2346 x 1568 pixels.
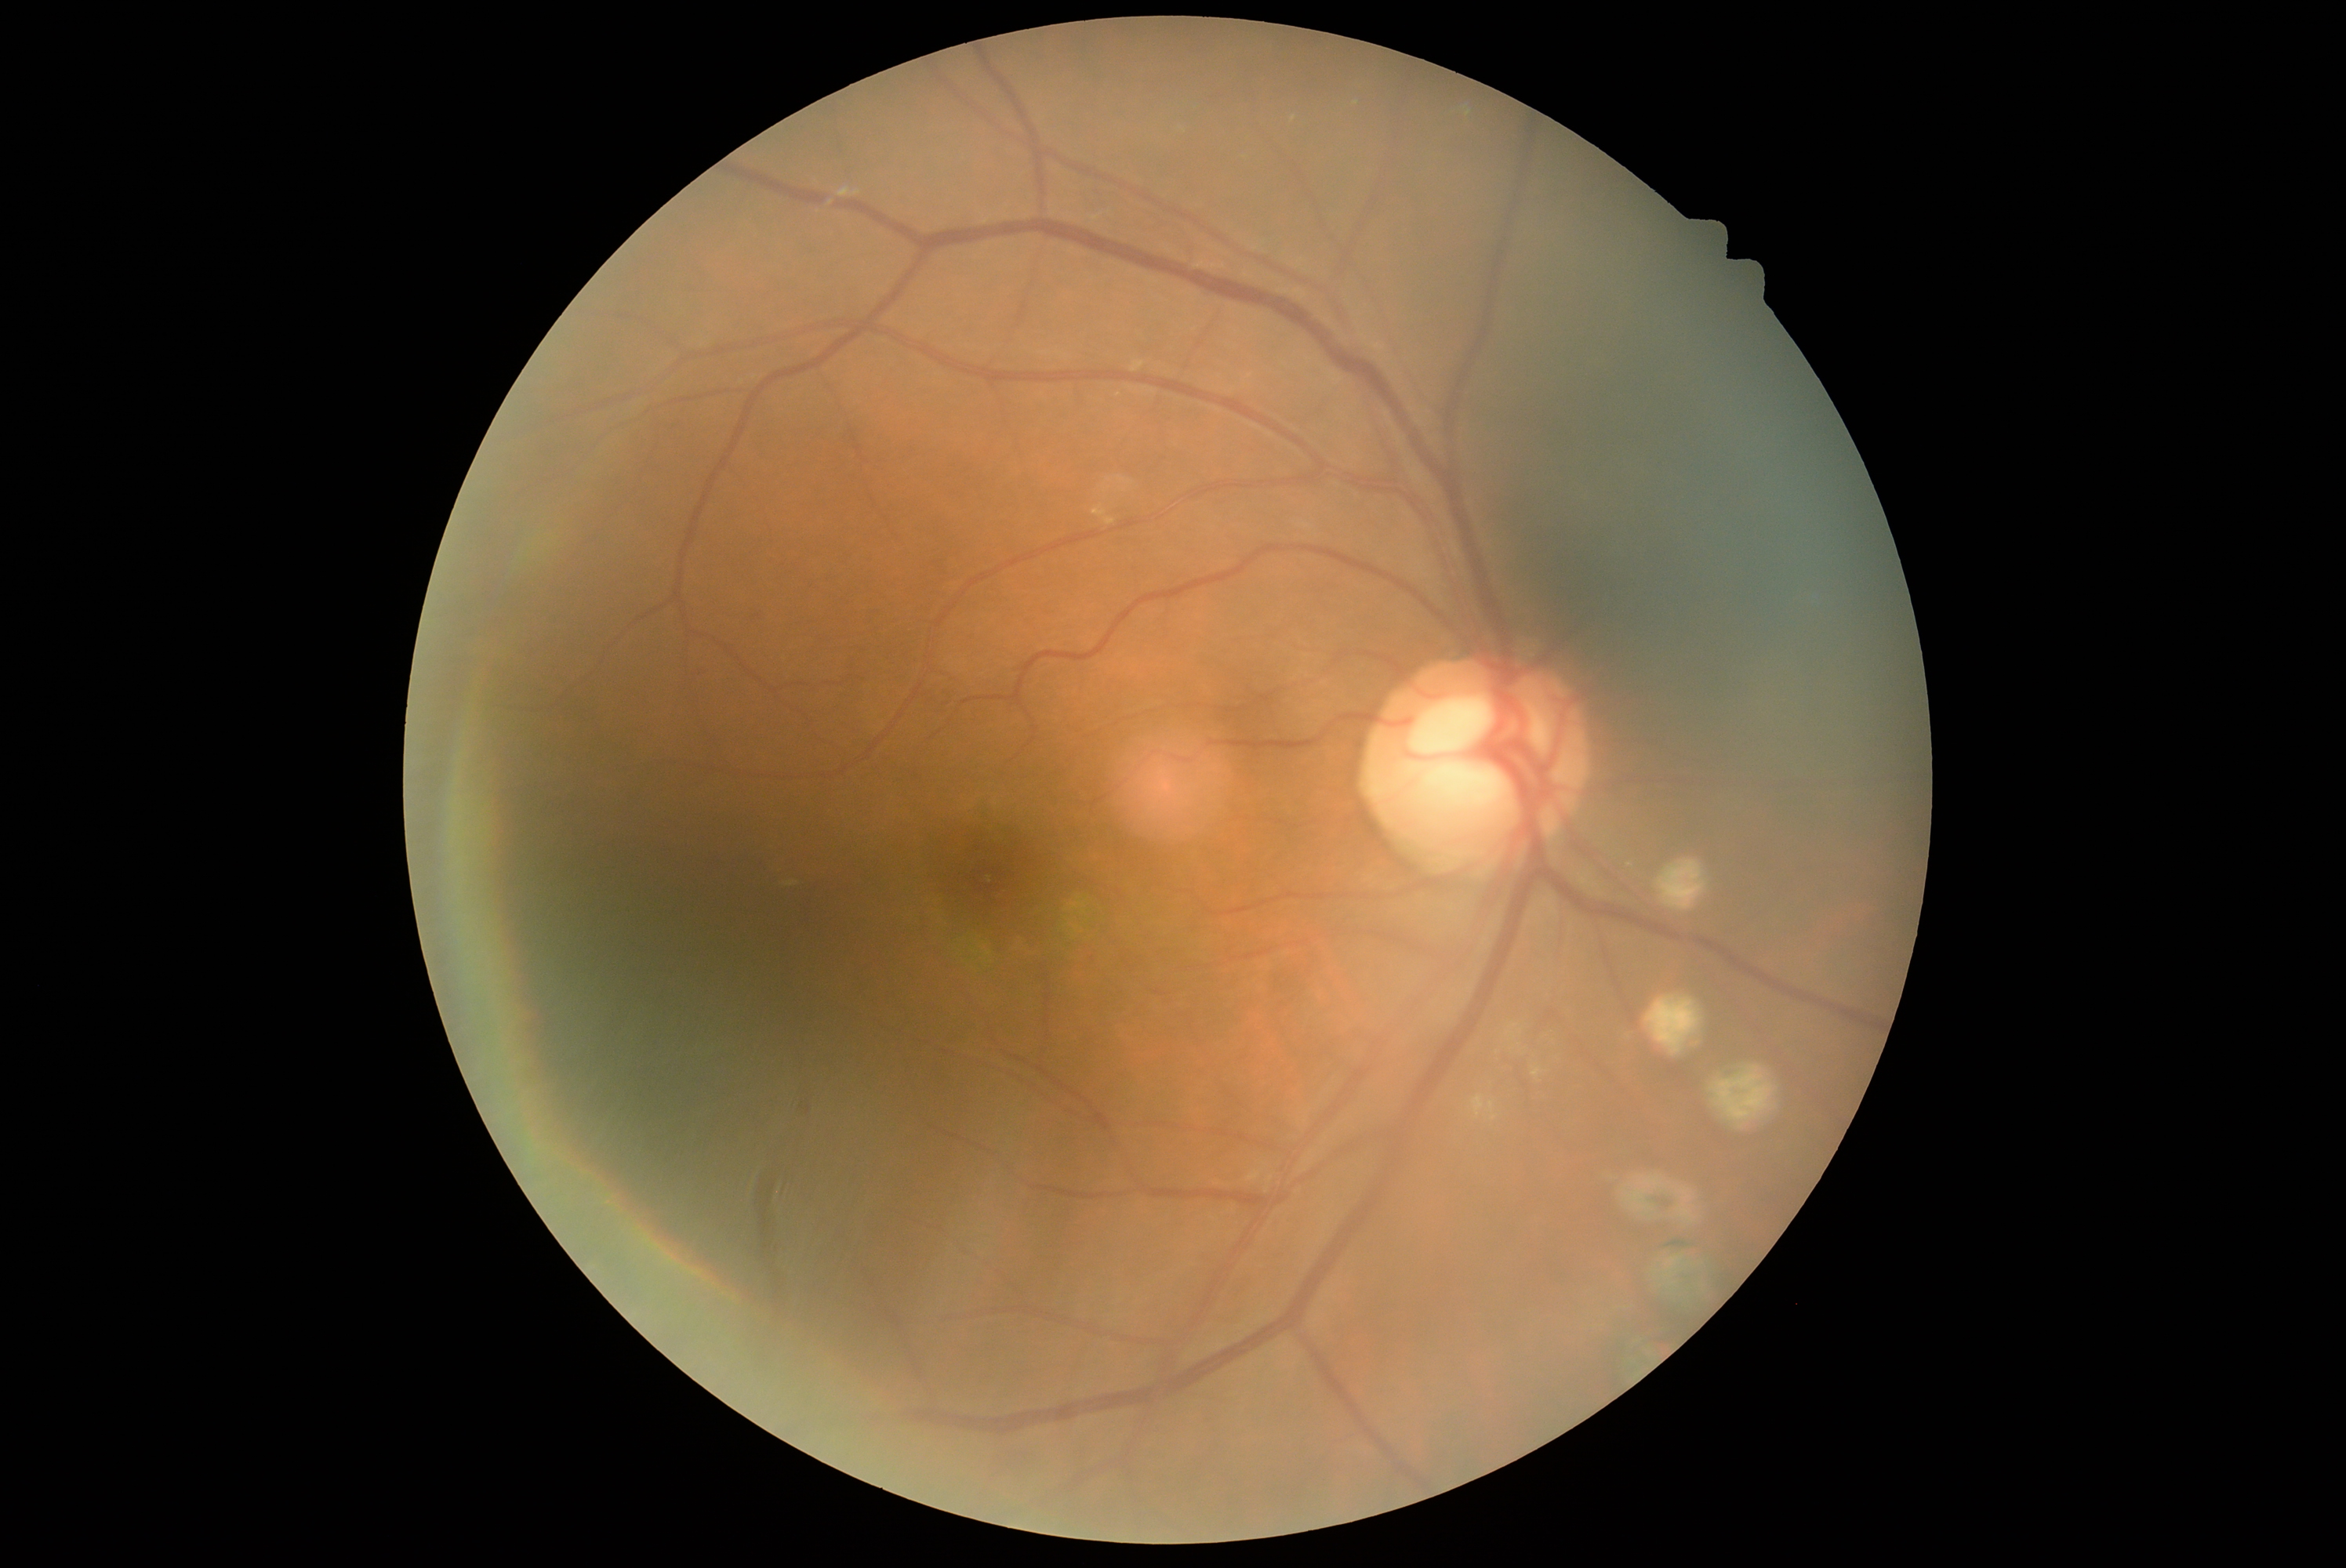 Diabetic retinopathy (DR) is moderate non-proliferative diabetic retinopathy (grade 2). DR class: non-proliferative diabetic retinopathy.